Color fundus photograph — 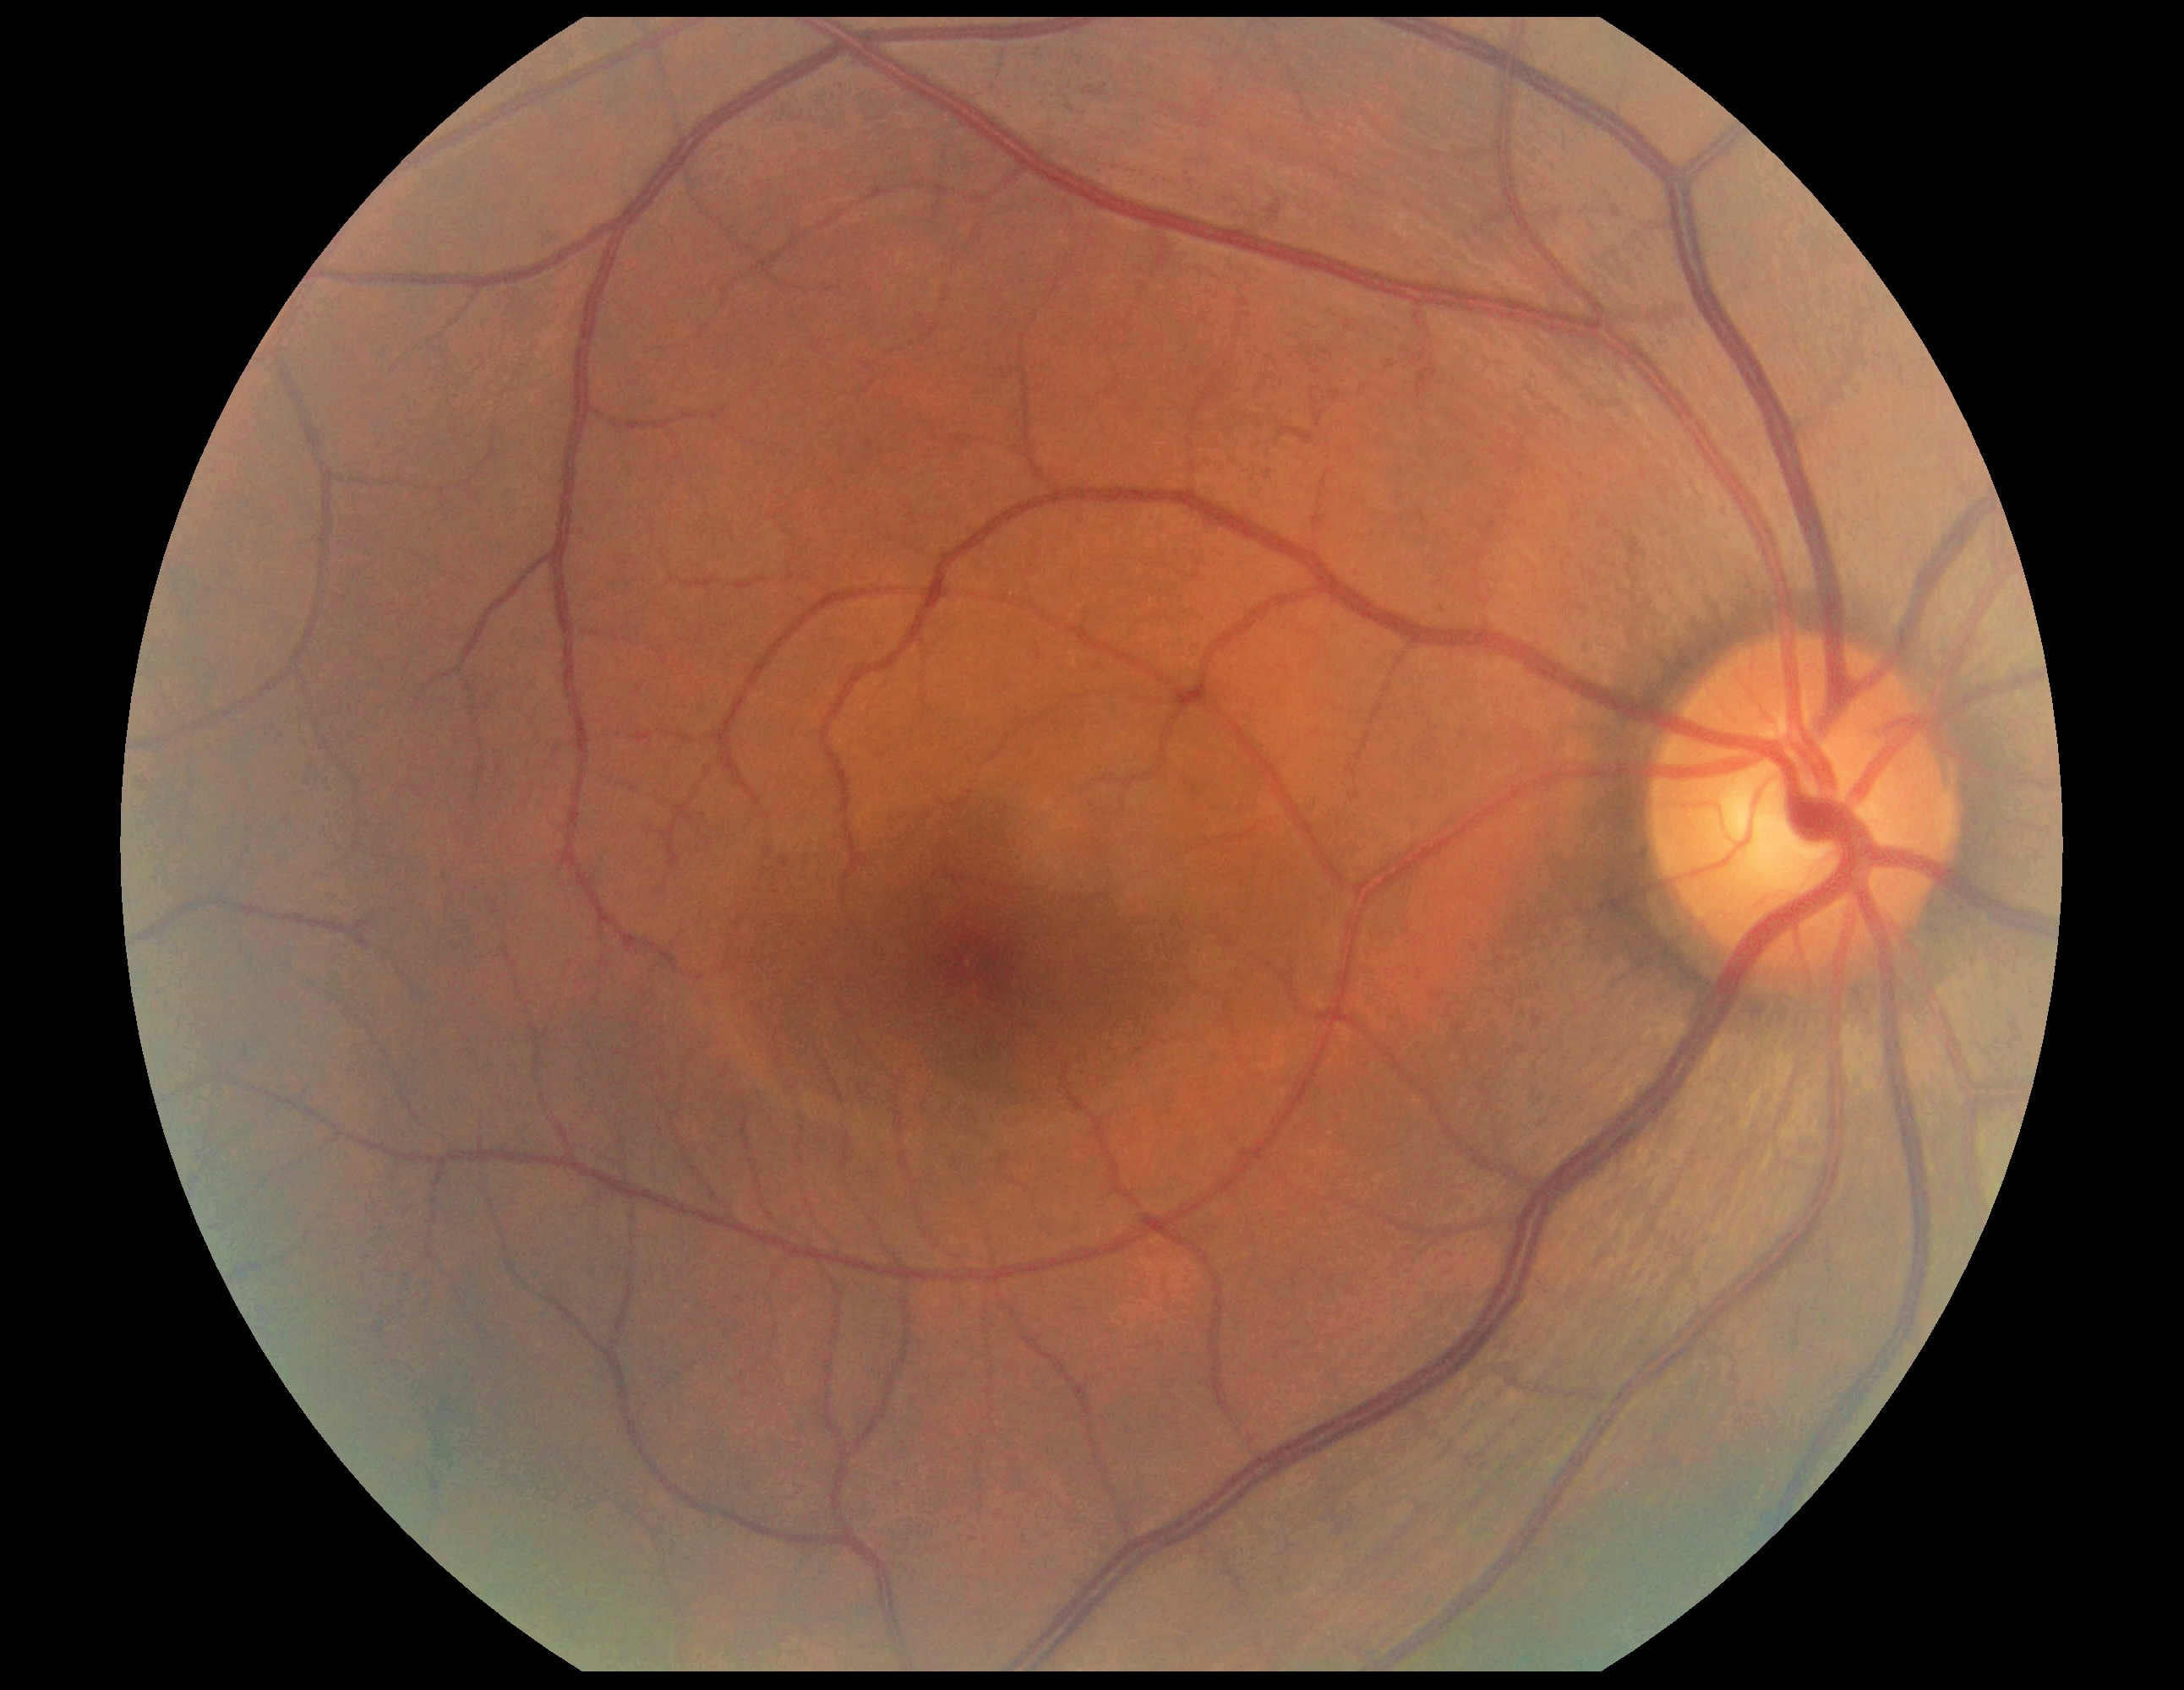

Retinopathy grade: no apparent diabetic retinopathy (0). No diabetic retinal disease findings.